Acquired with a Topcon TRC-50DX: 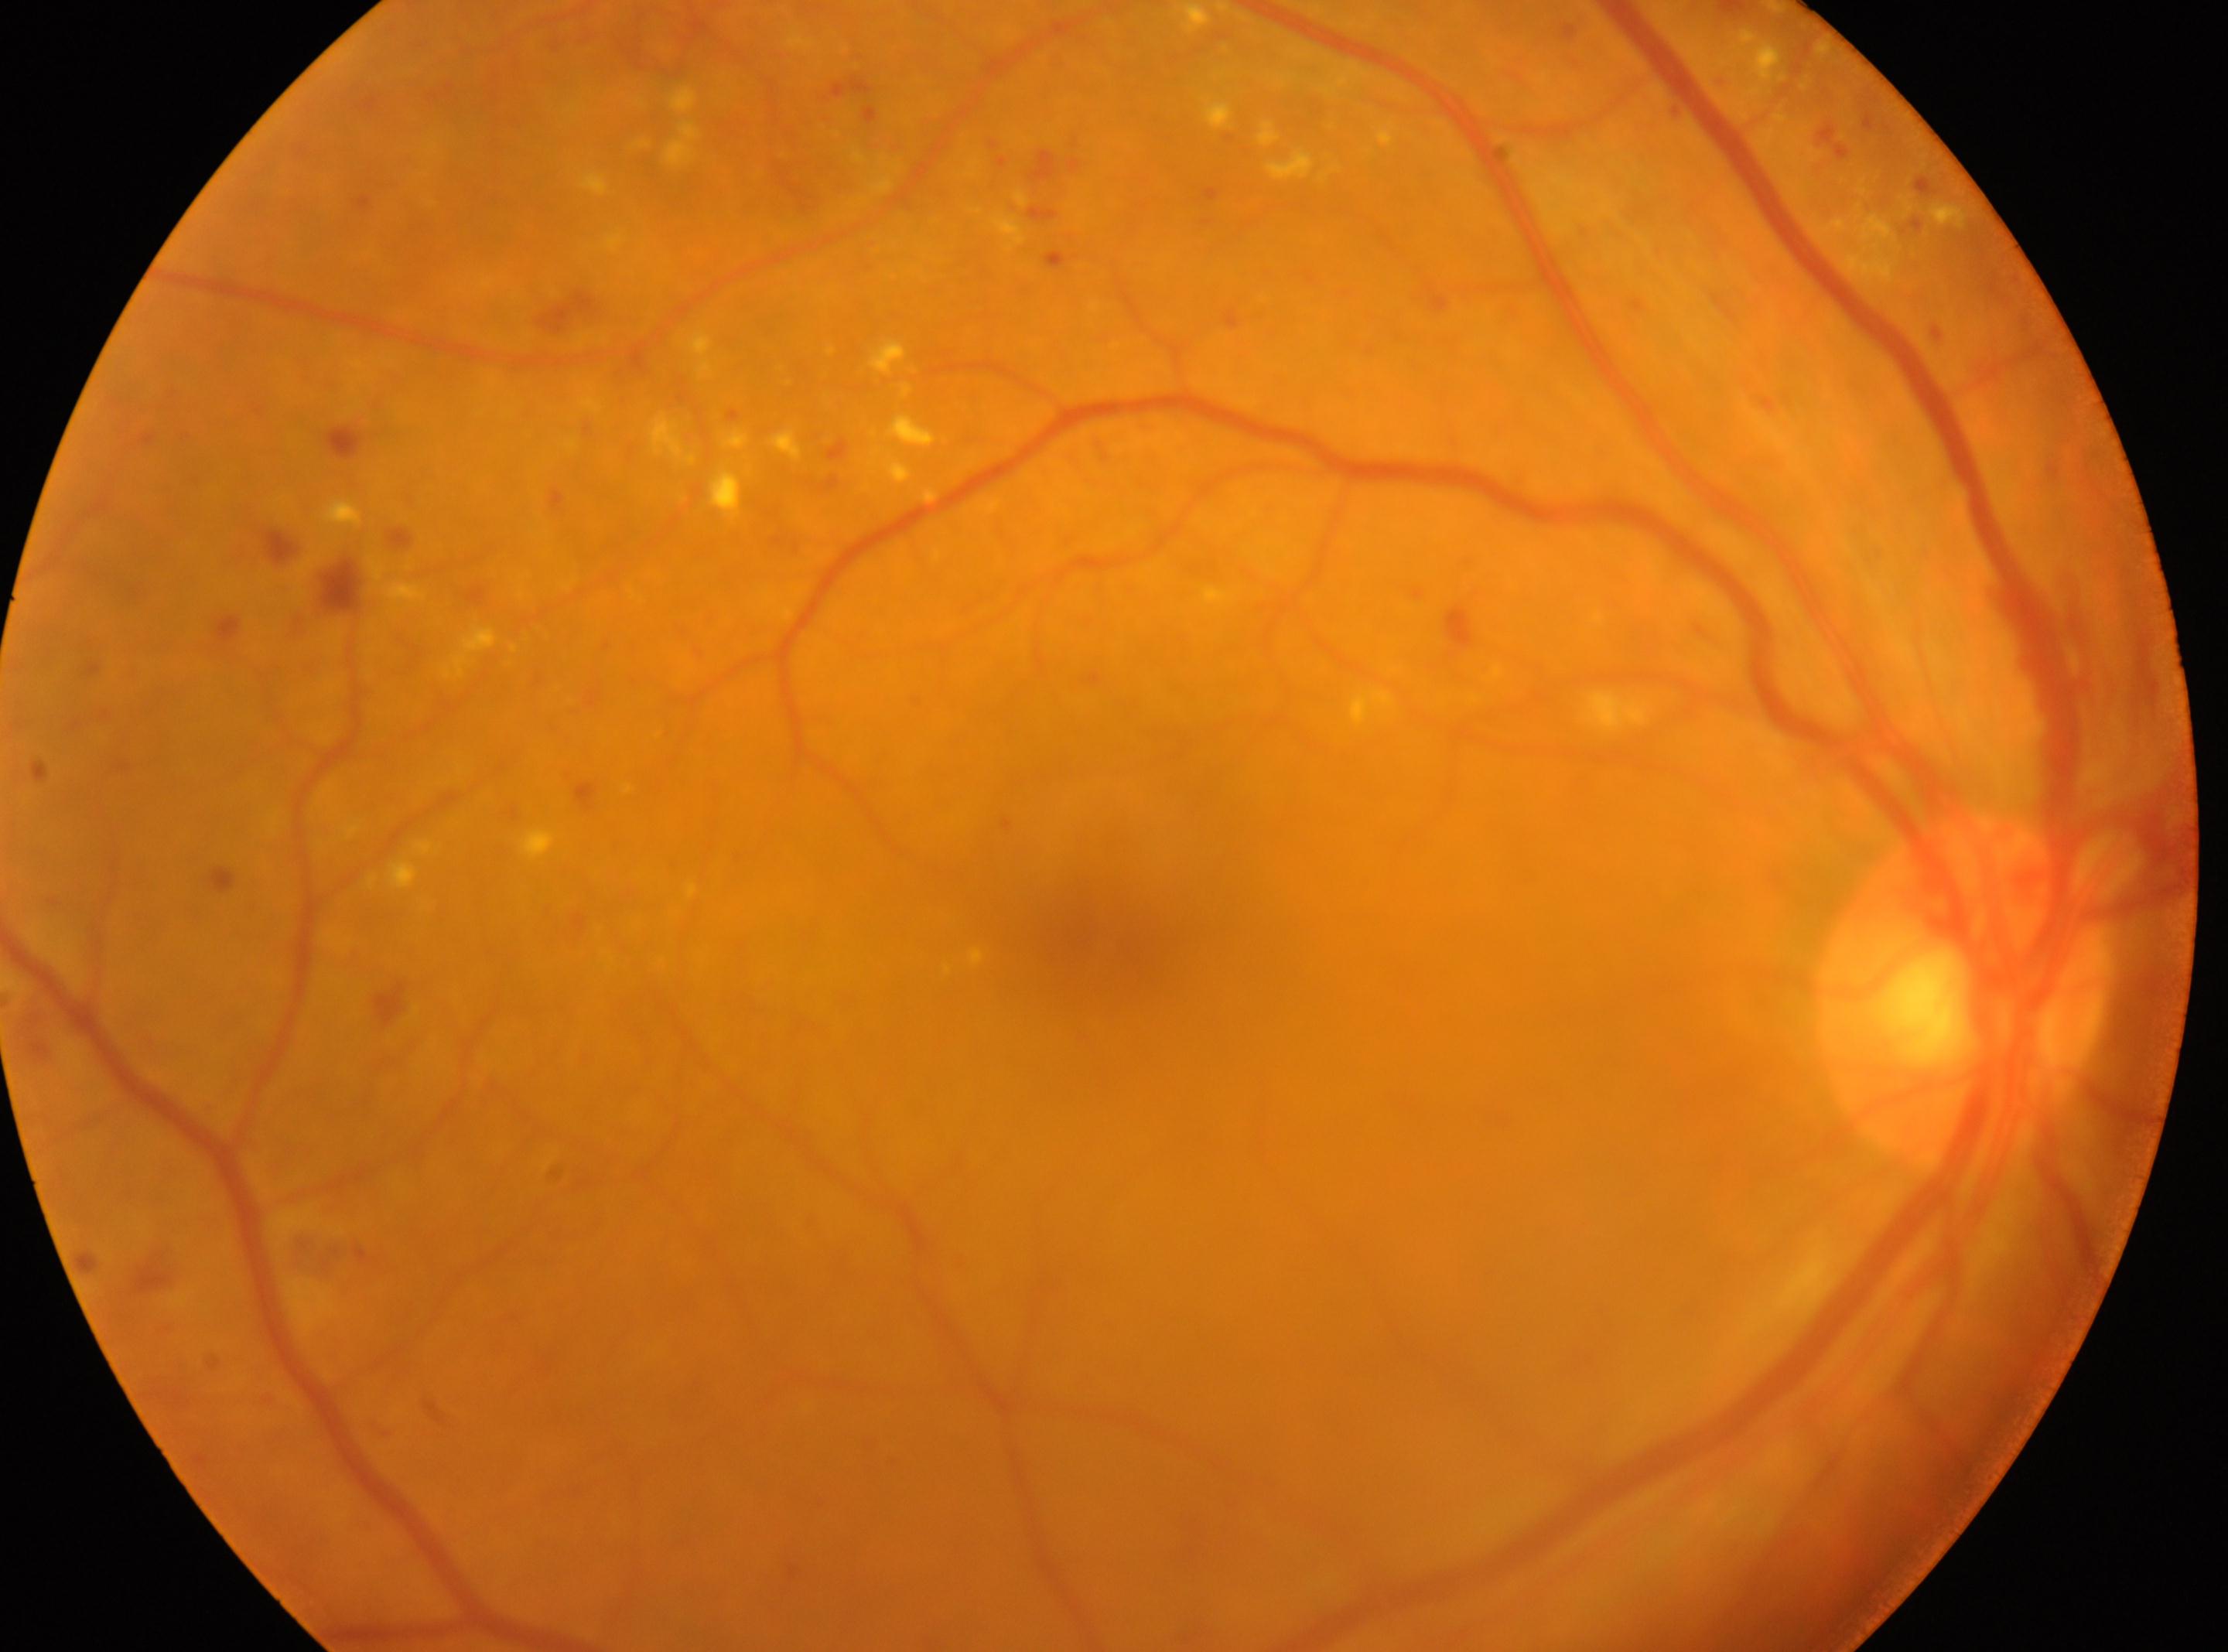
The retinopathy is classified as non-proliferative diabetic retinopathy.
The fovea center is at 1088, 933.
Diabetic retinopathy severity: grade 2 (moderate NPDR).
The image shows the OD.
Optic disc located at 1963, 992.